Pediatric retinal photograph (wide-field) · 1240 x 1240 pixels: 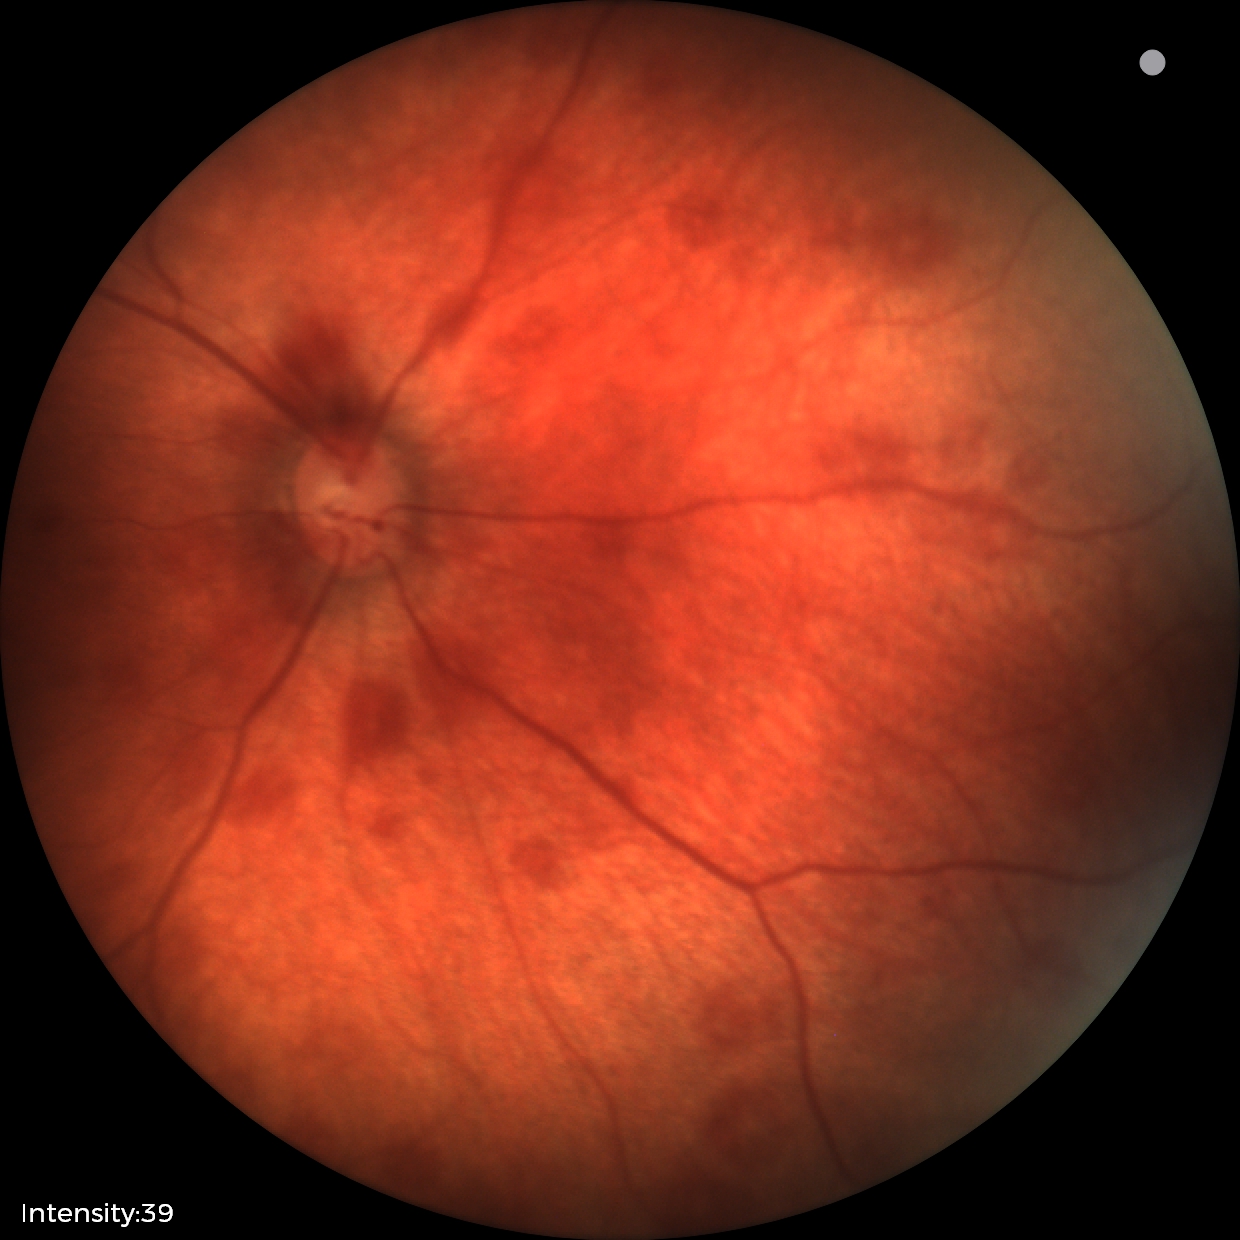

Screening examination consistent with retinal hemorrhages.